848x848.
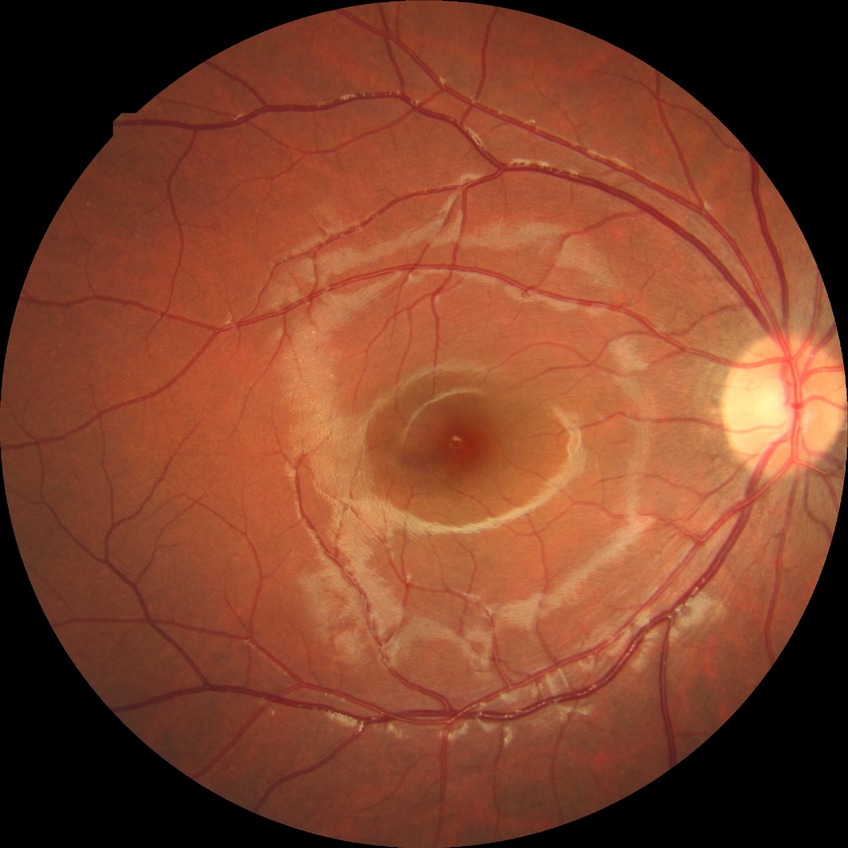
Diabetic retinopathy (DR) is no diabetic retinopathy (NDR).